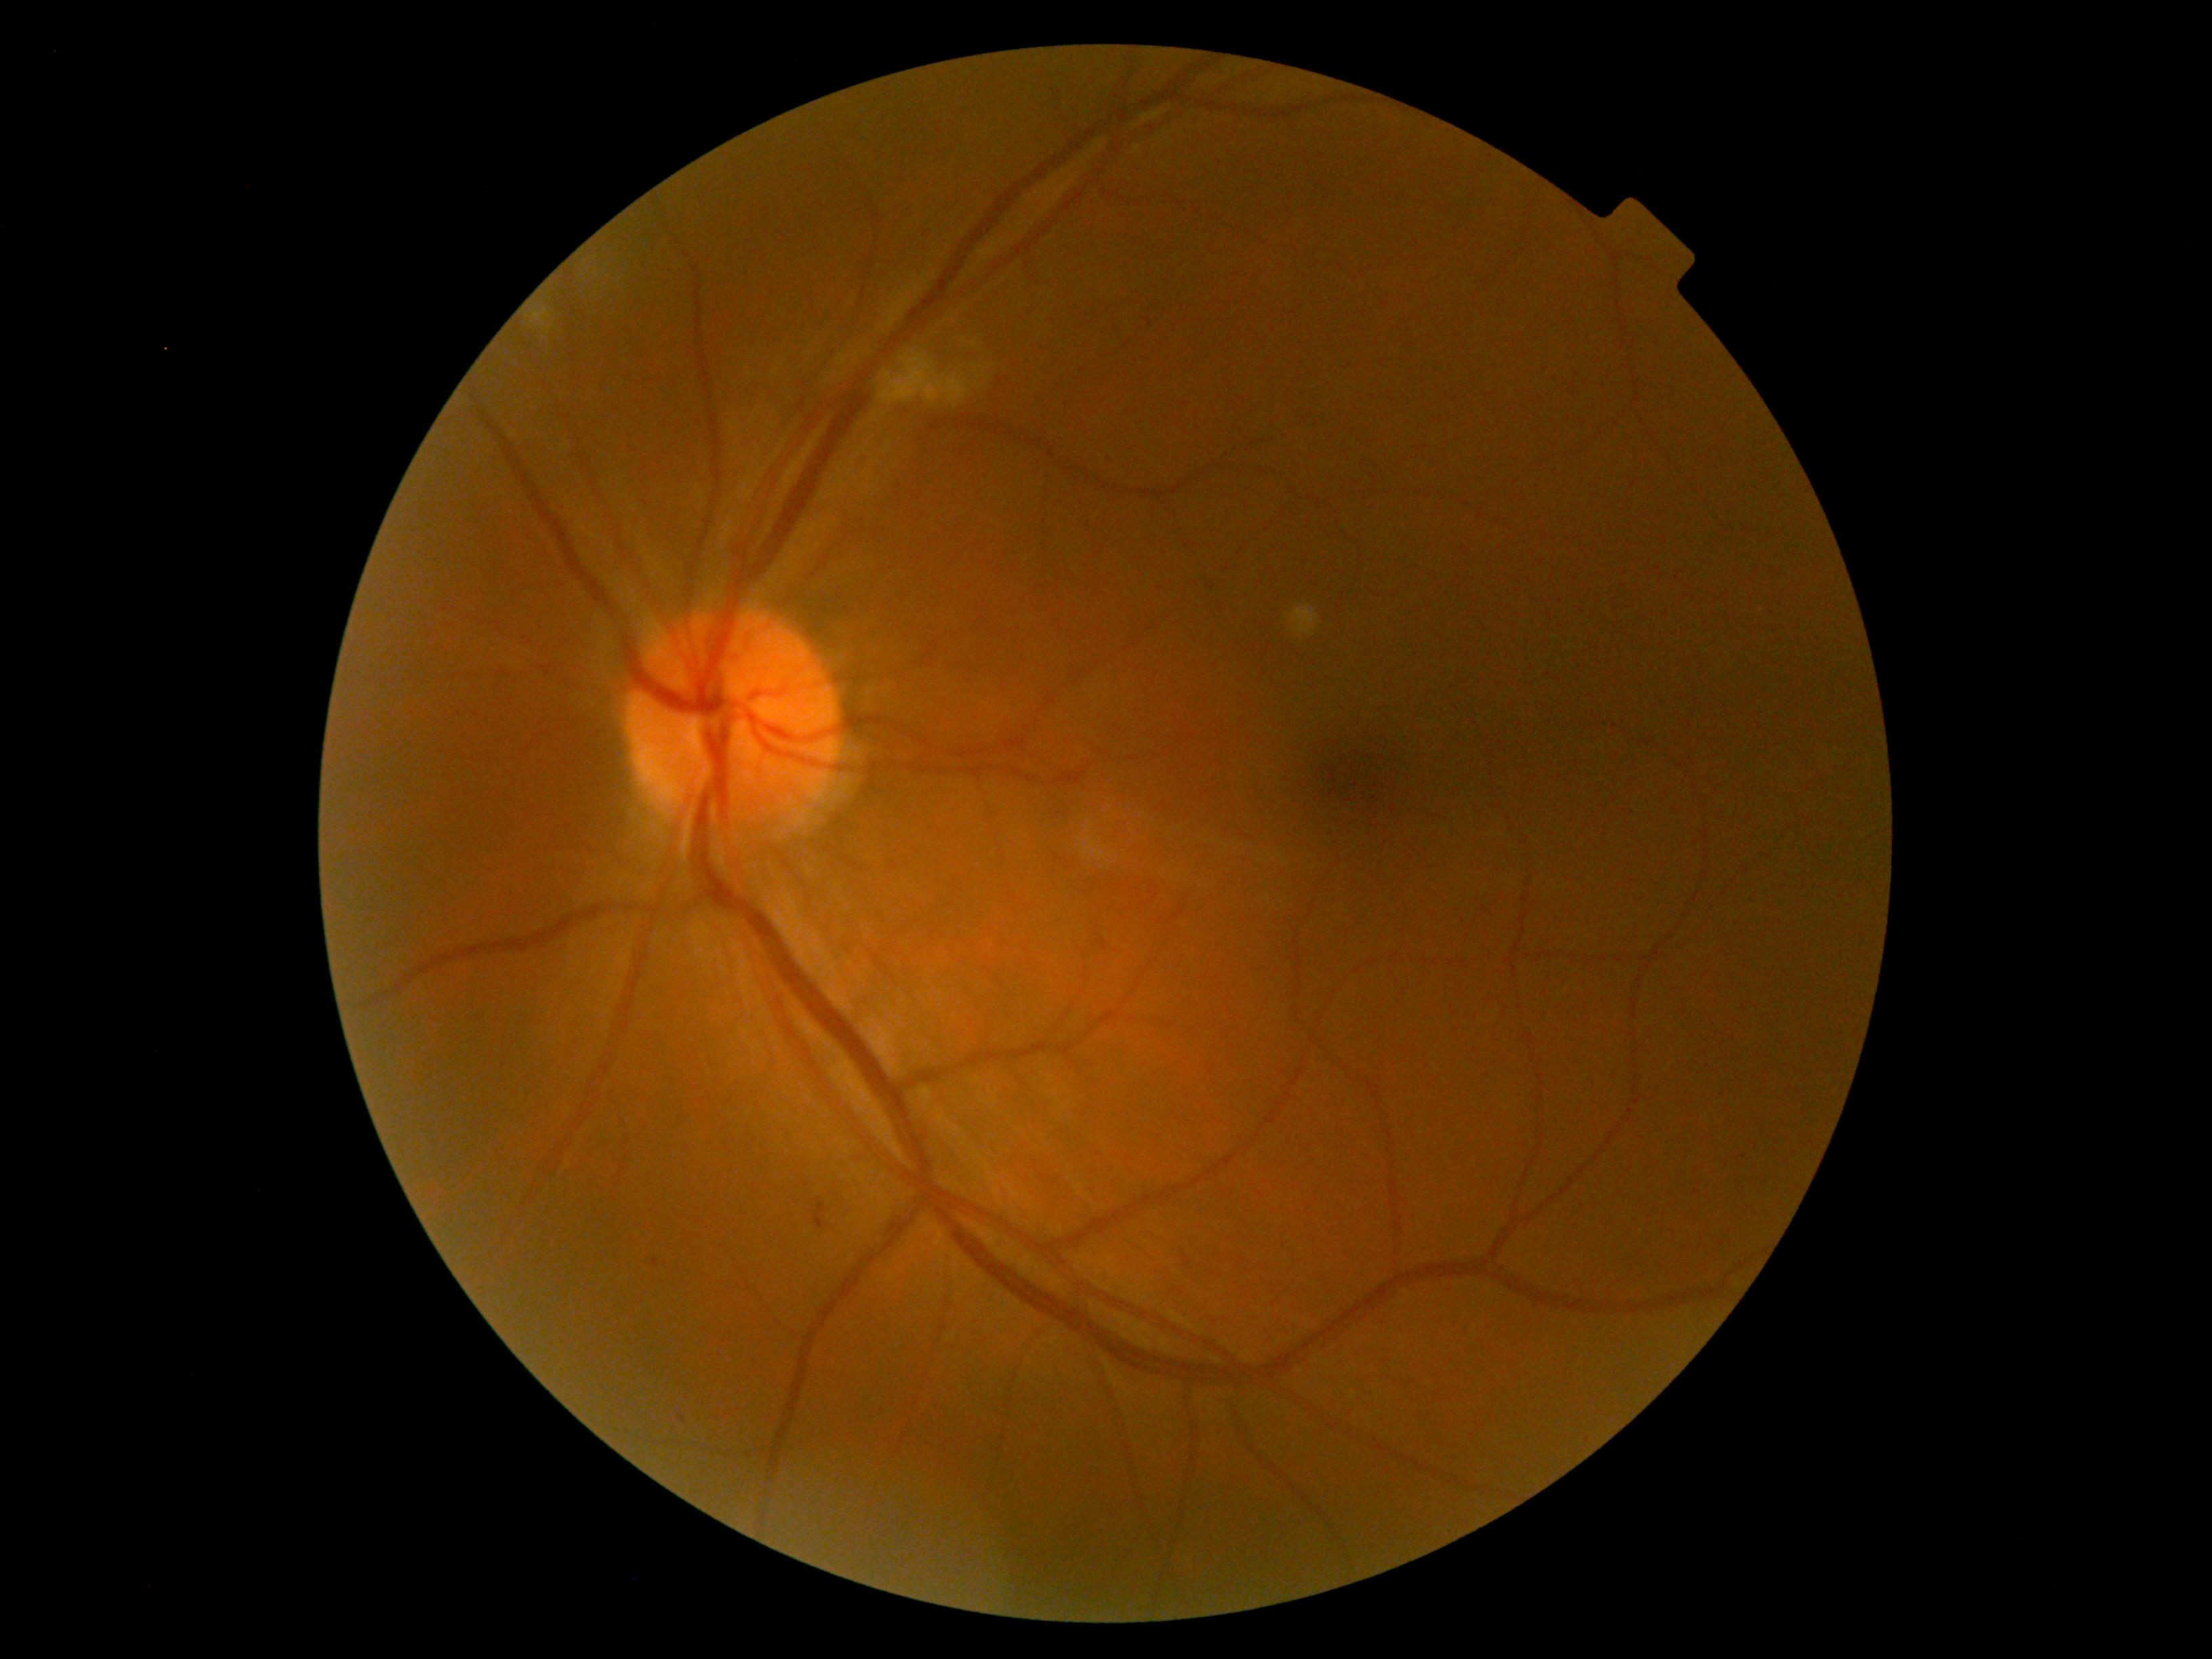 Retinopathy: grade 2 (moderate NPDR).